Nonmydriatic. 848 by 848 pixels.
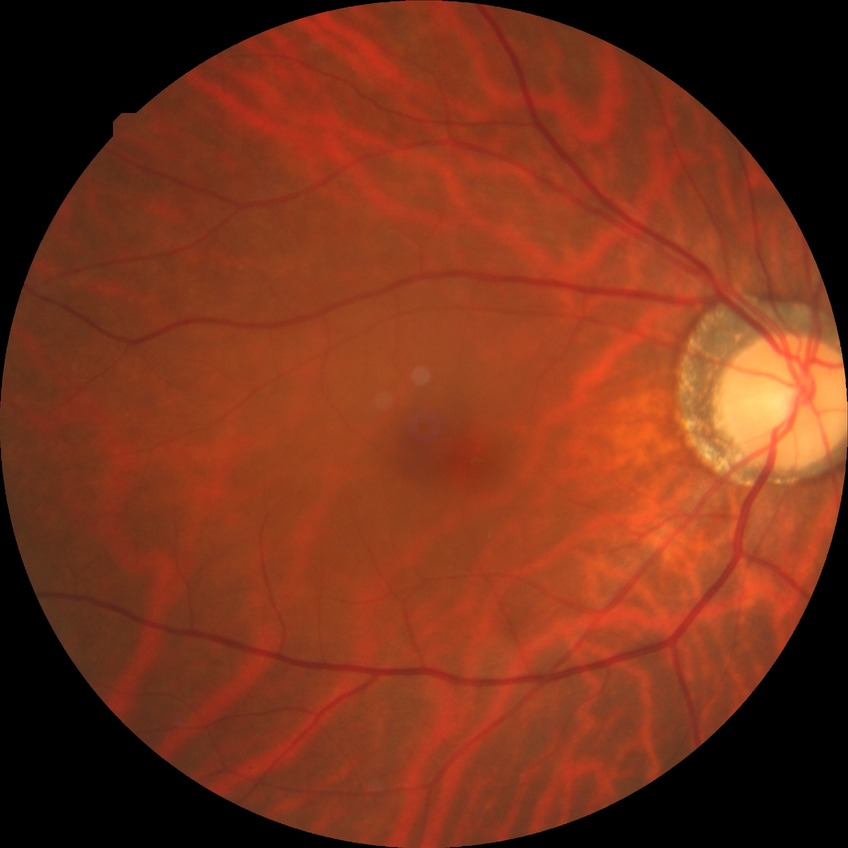
{
  "davis_grade": "no diabetic retinopathy"
}